Nonmydriatic. NIDEK AFC-230 fundus camera. 848 by 848 pixels
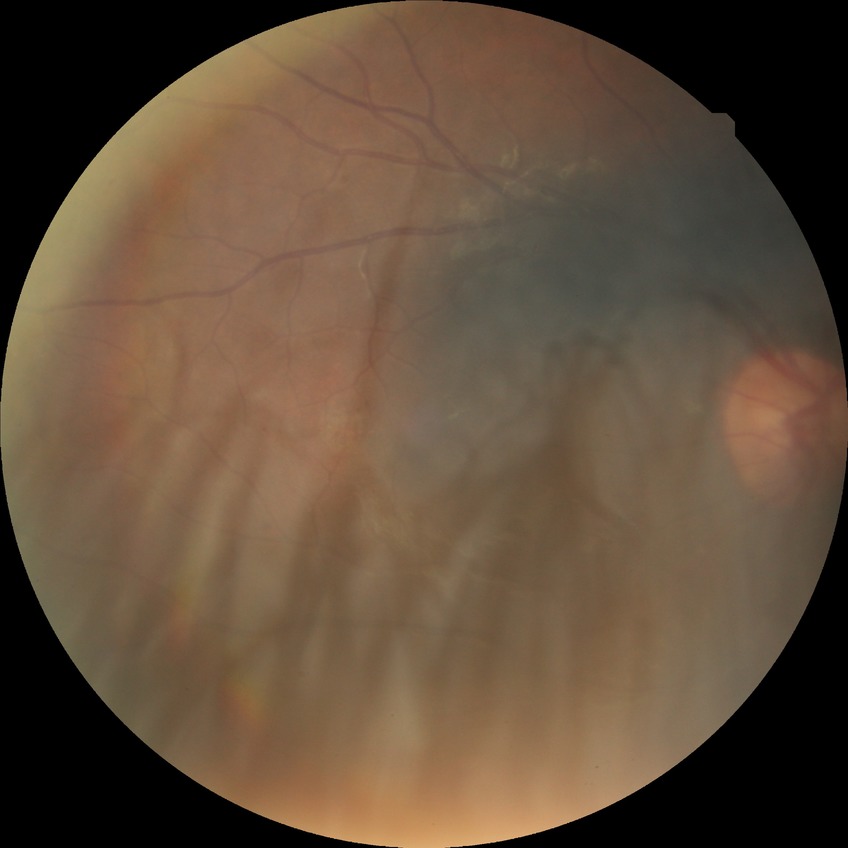
Diabetic retinopathy (DR): simple diabetic retinopathy (SDR).